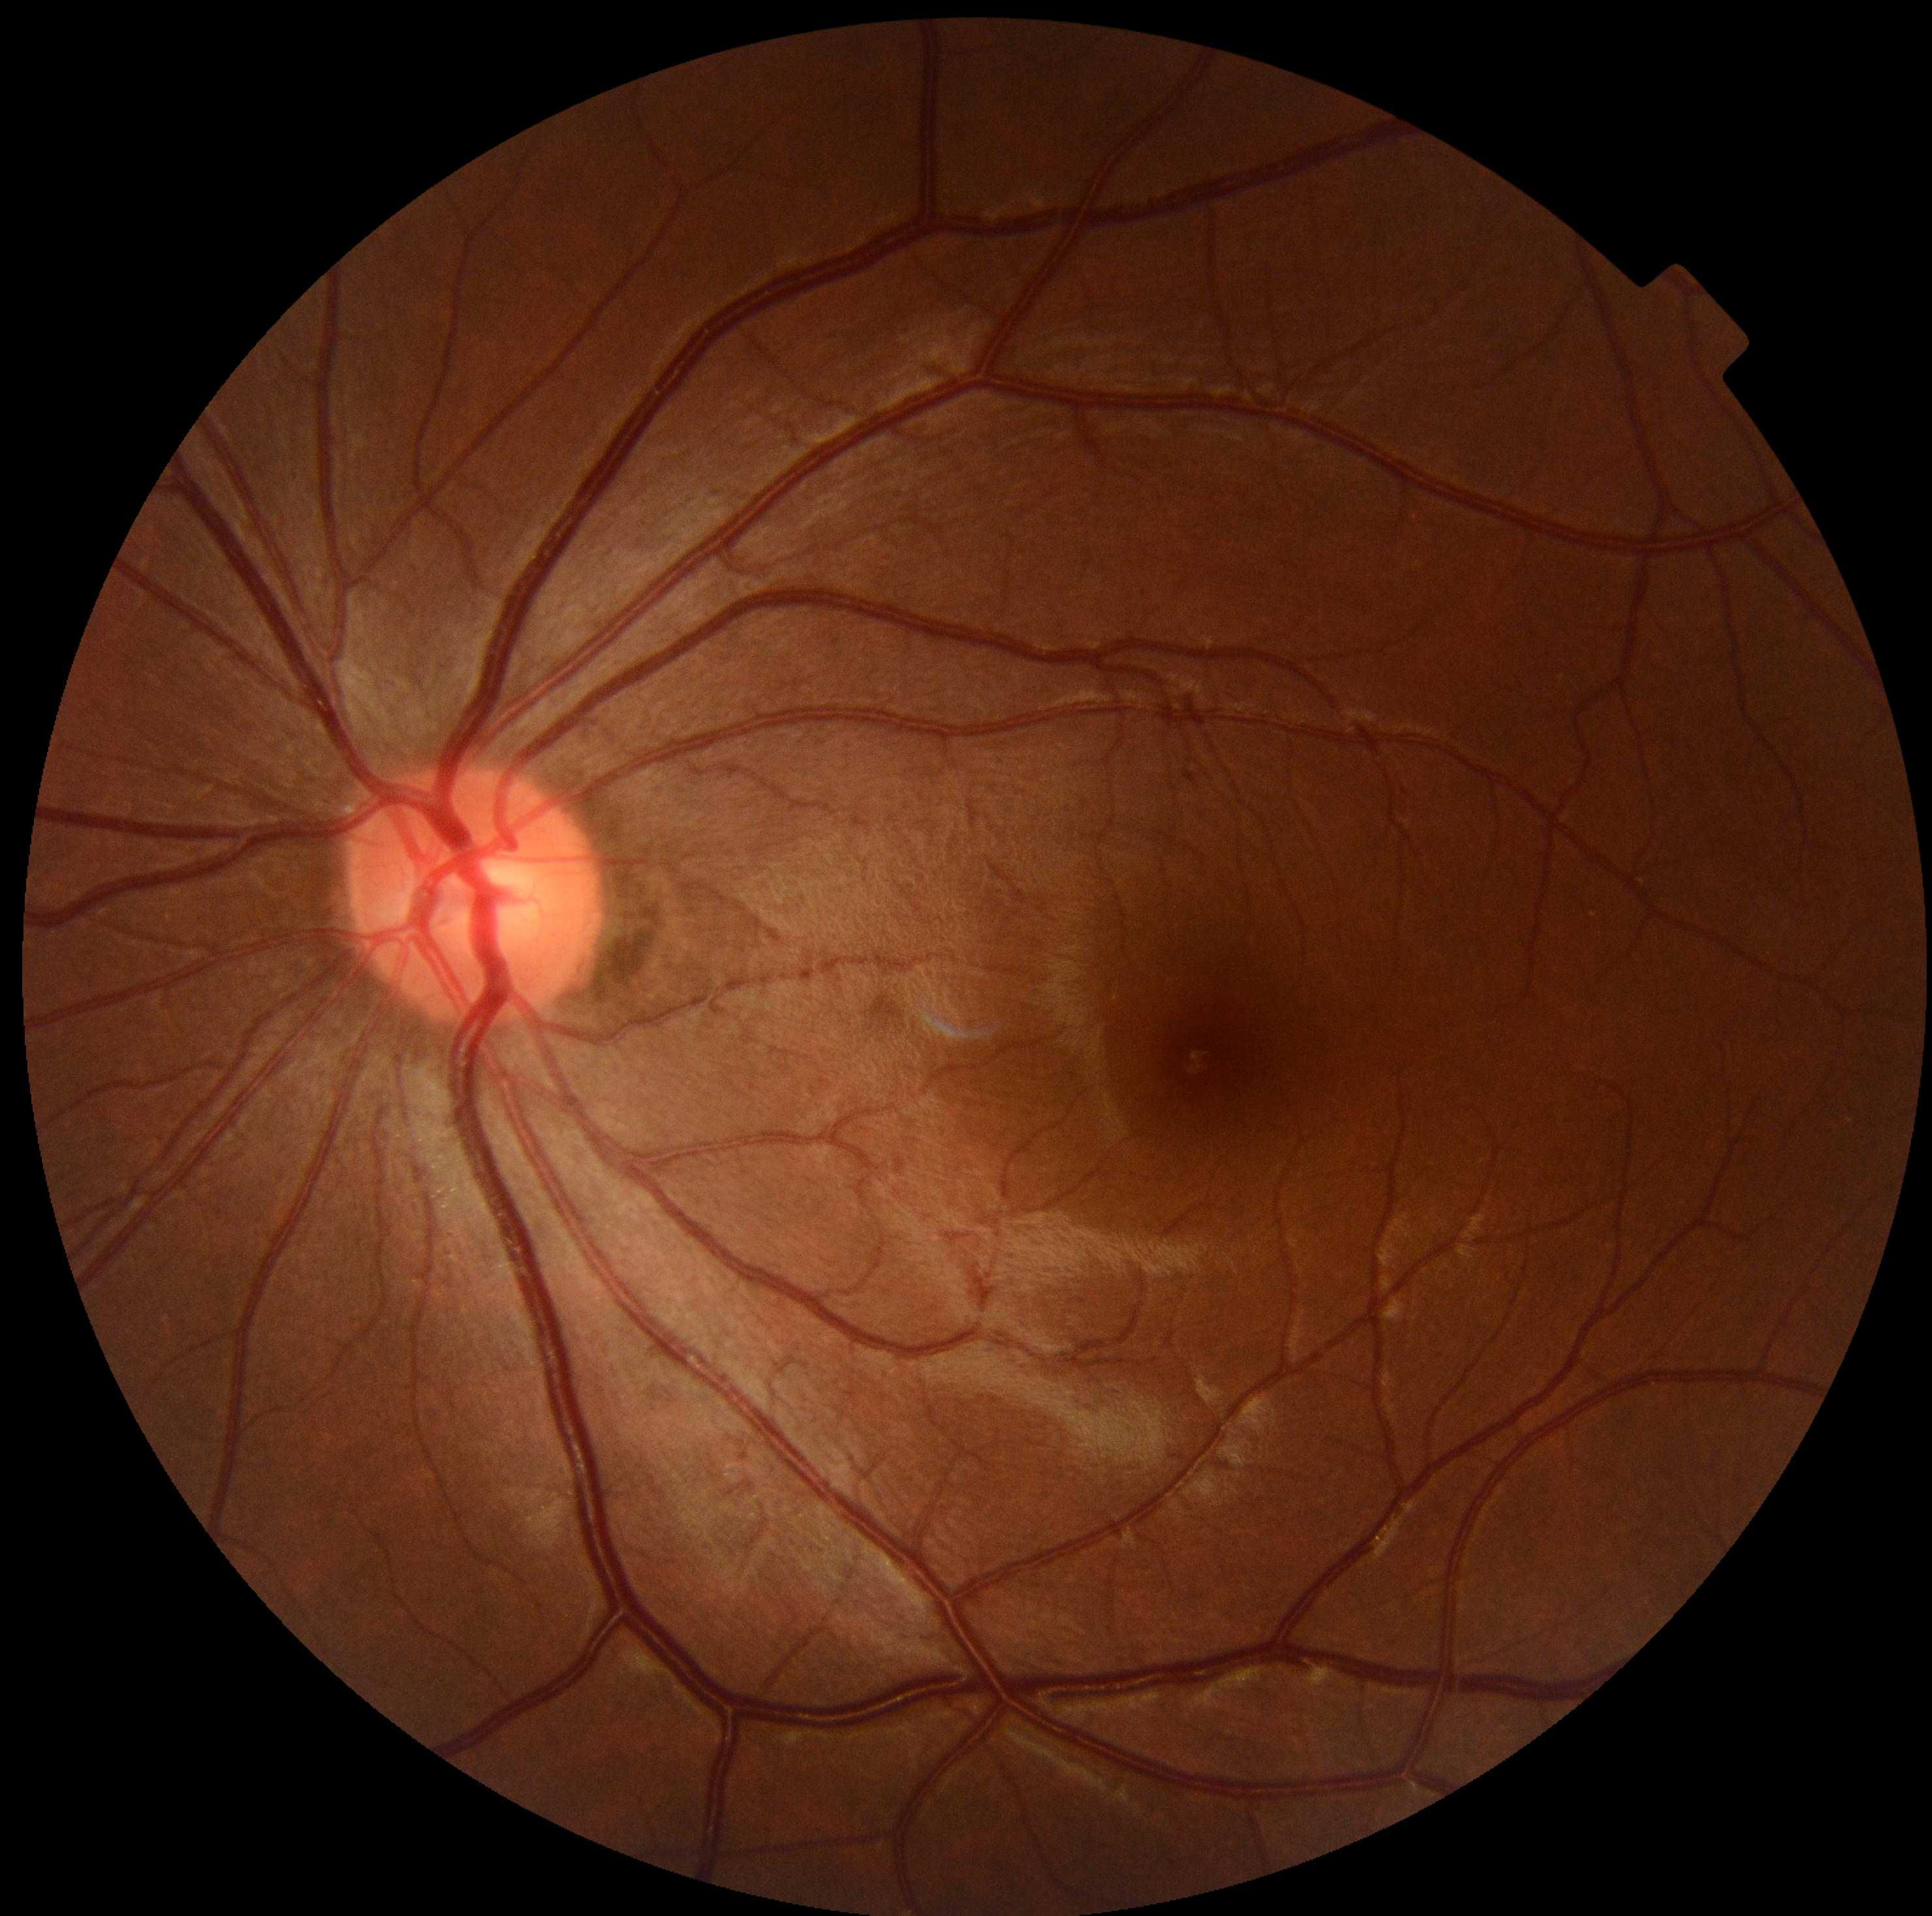
DR severity is grade 0 (no apparent retinopathy) — no visible signs of diabetic retinopathy.